45° FOV, image size 848x848, NIDEK AFC-230 fundus camera, modified Davis classification.
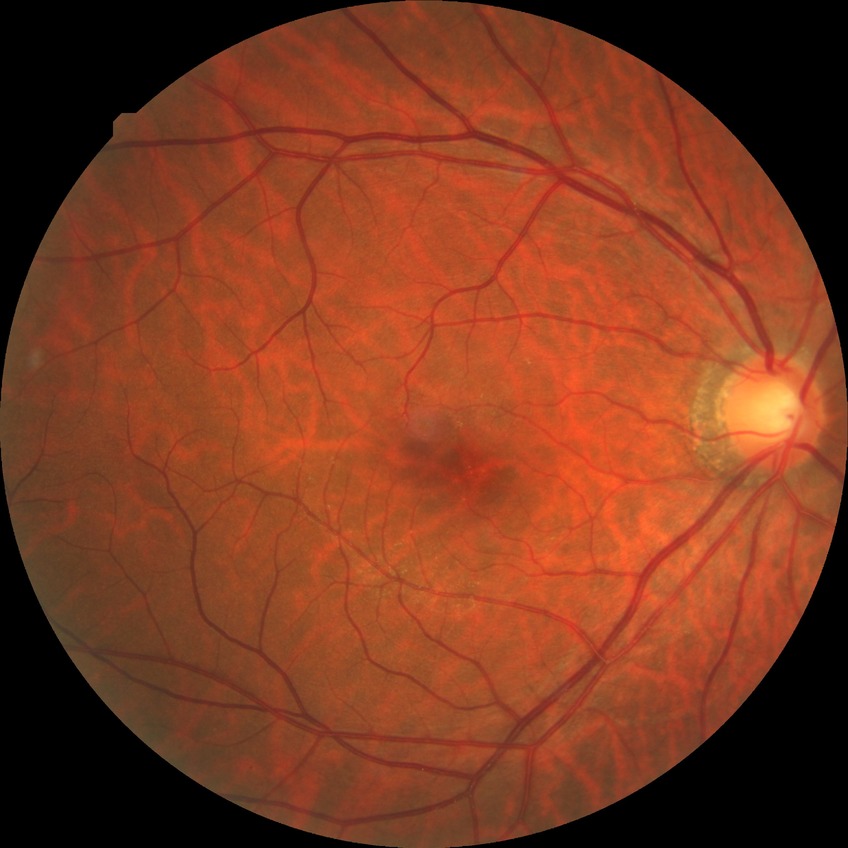 Diabetic retinopathy (DR): no diabetic retinopathy (NDR).